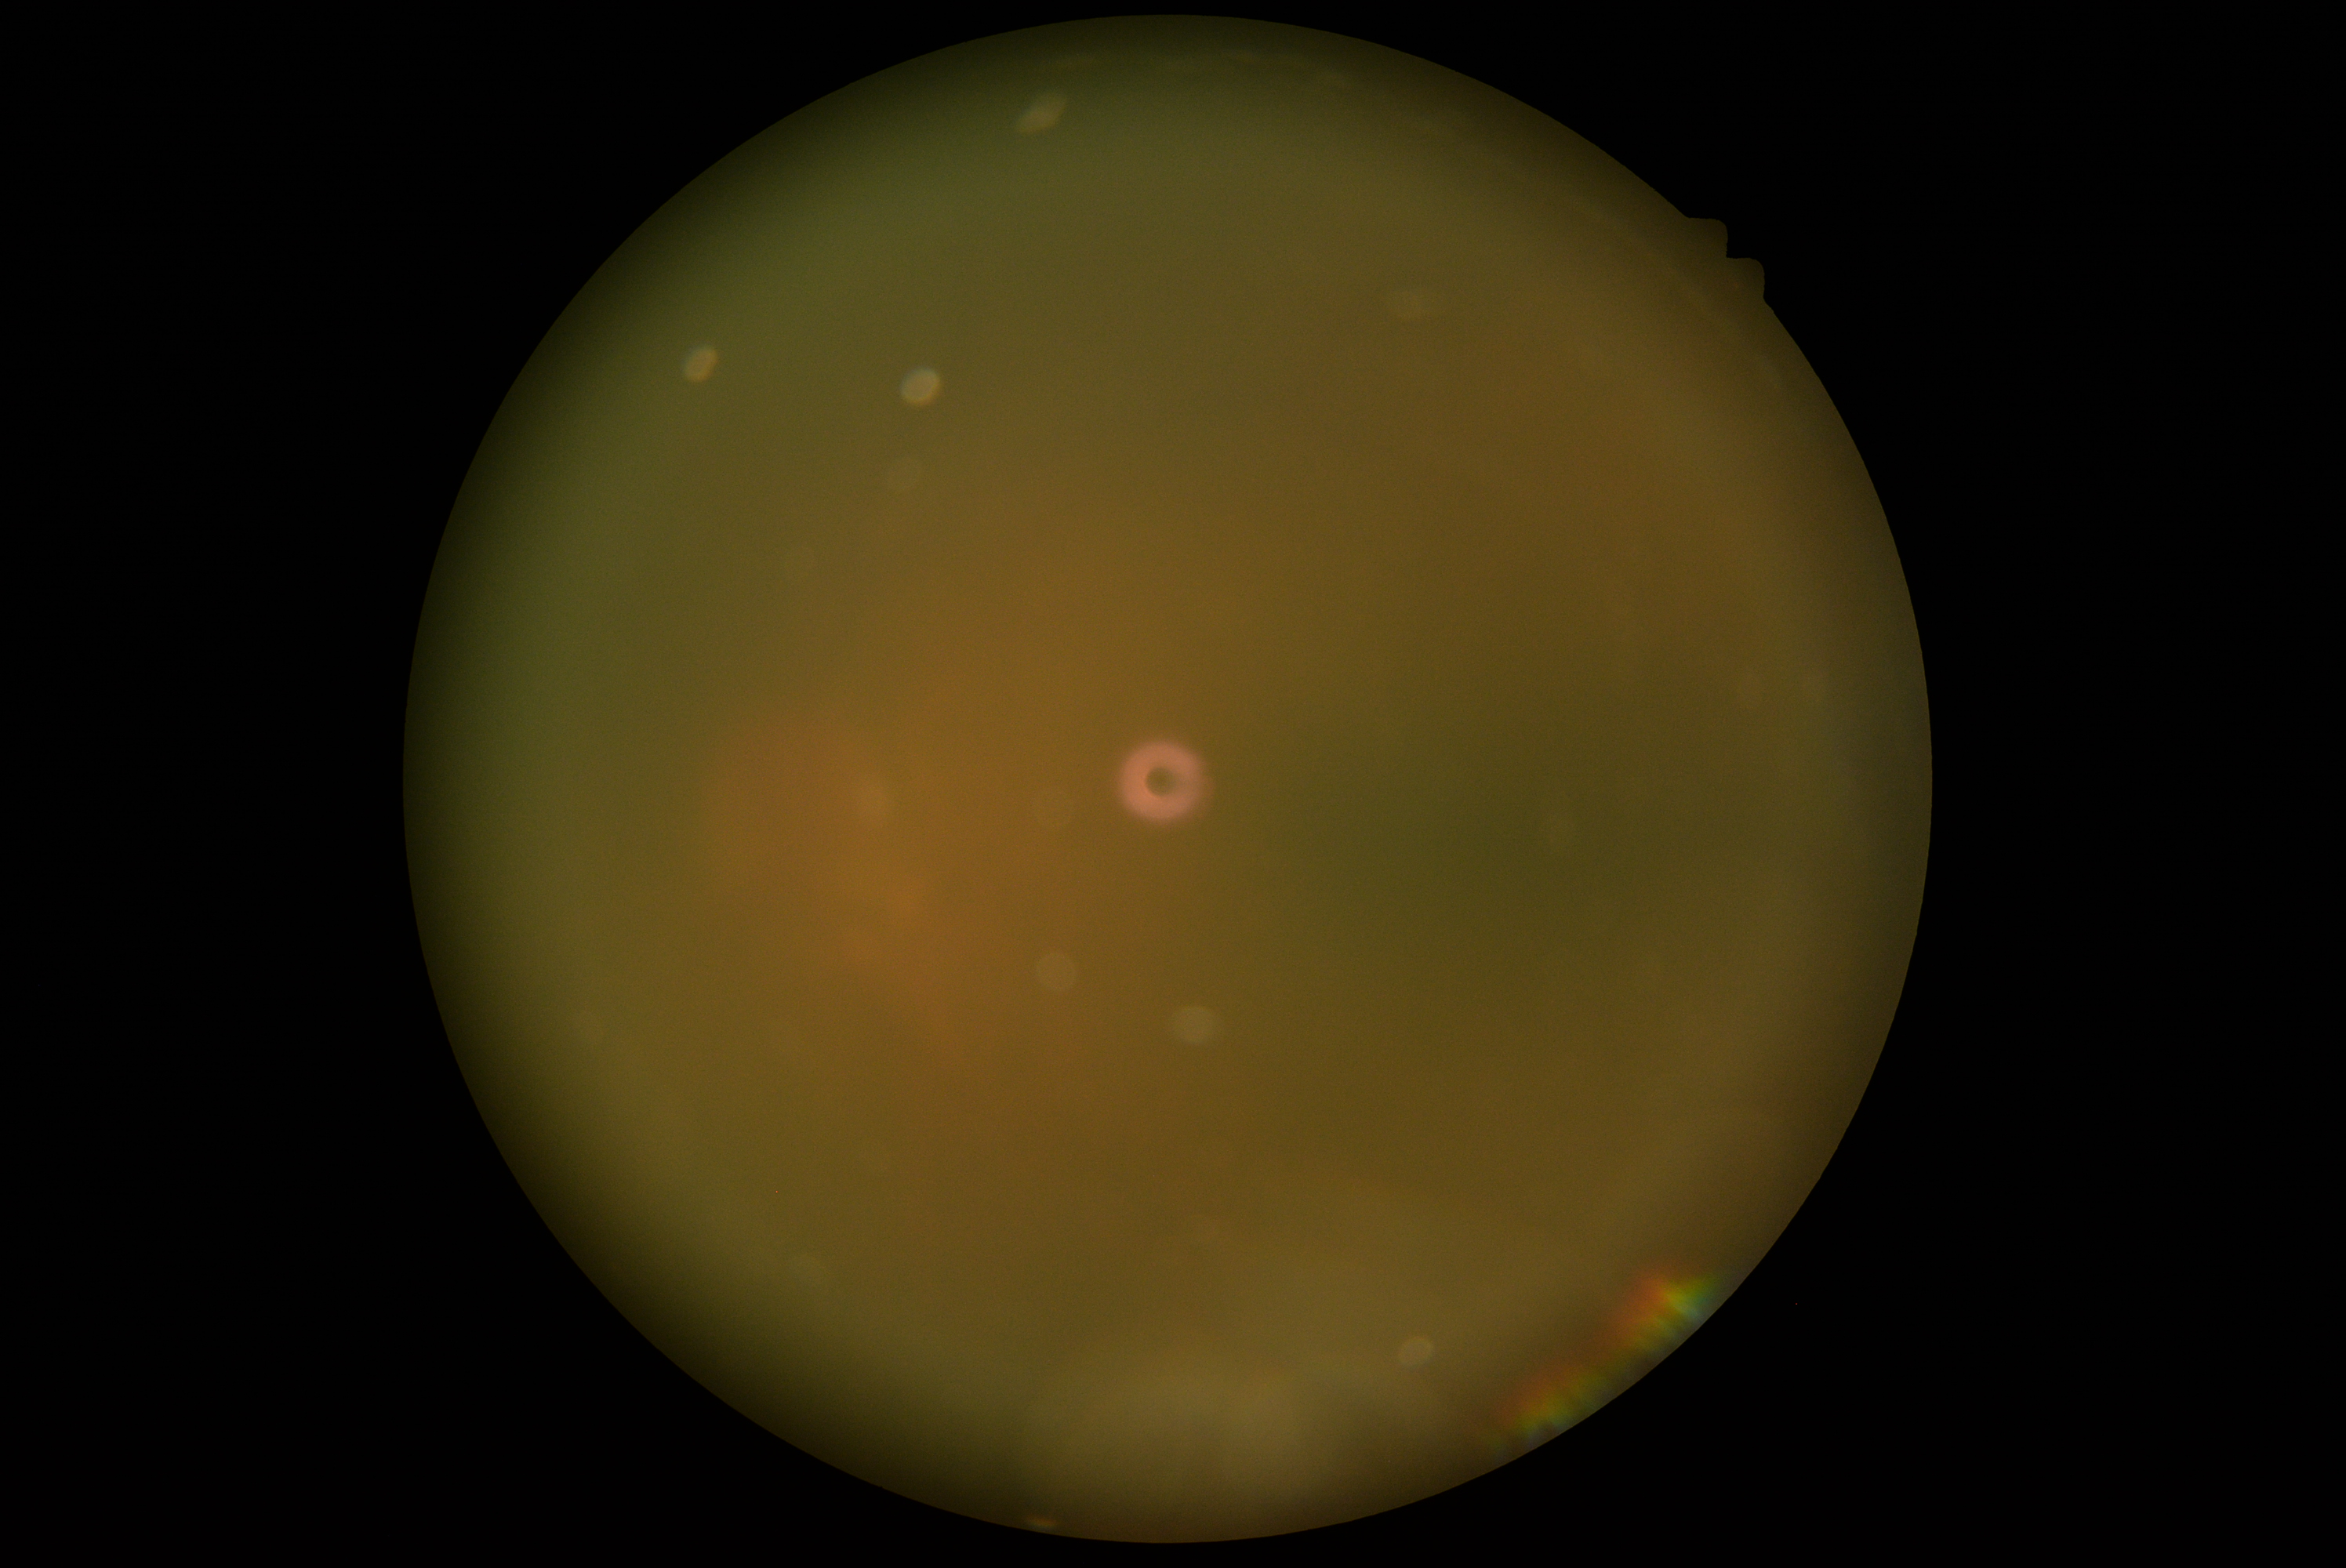
DR stage = ungradable.